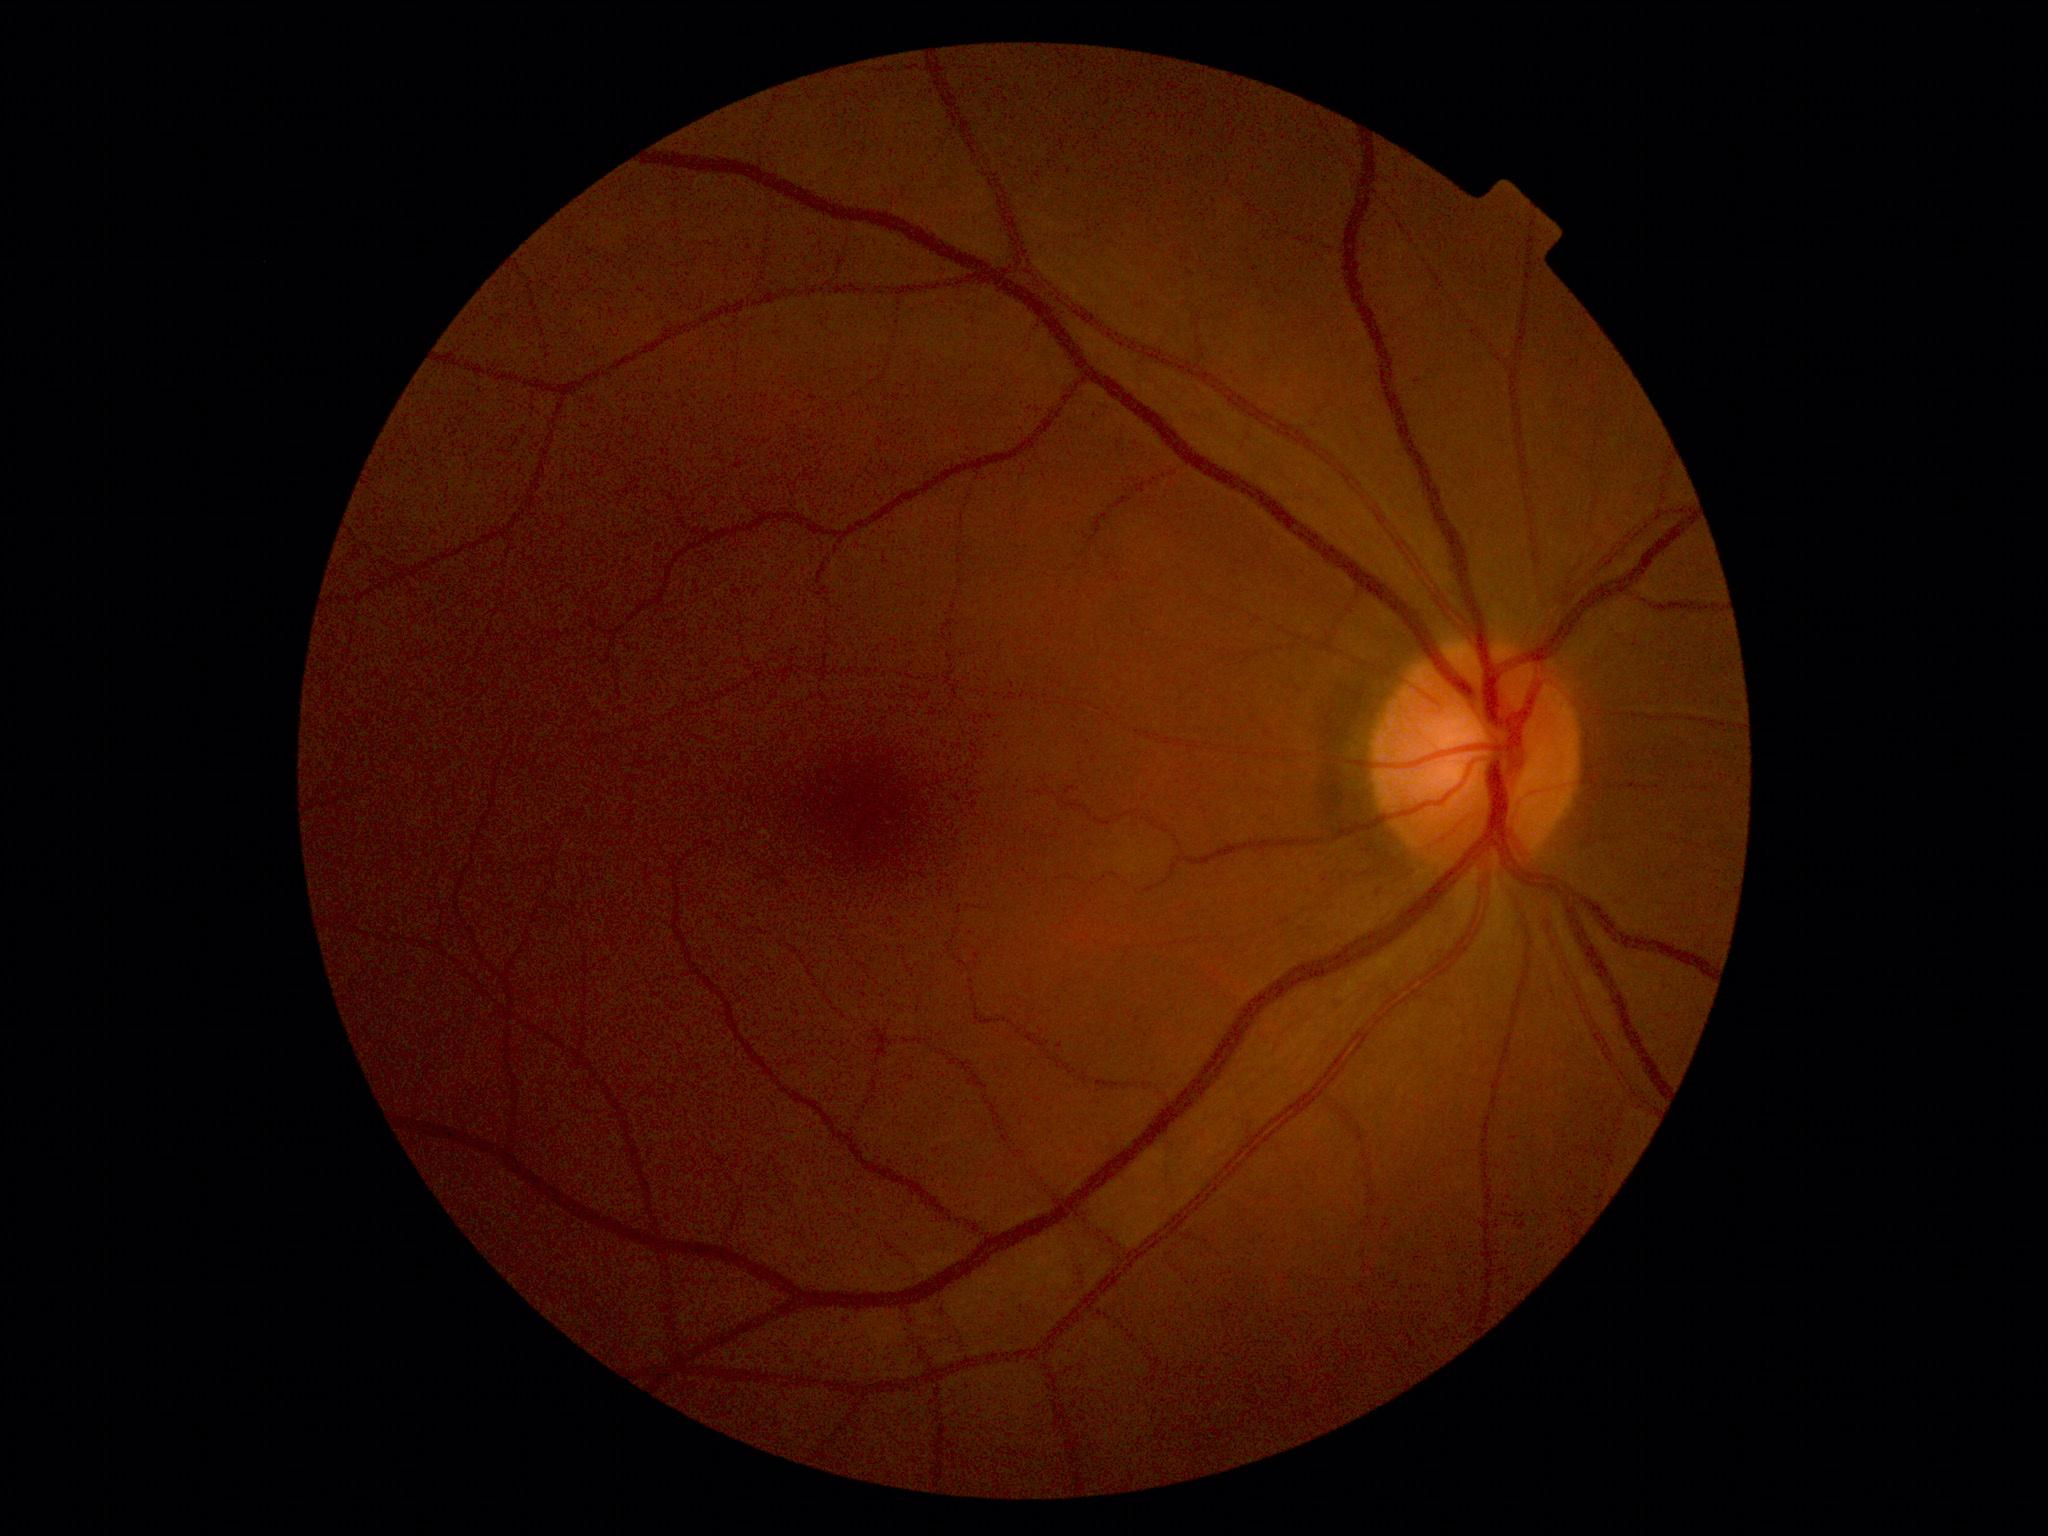 Retinopathy is grade 0 (no apparent retinopathy).